FOV: 45 degrees; 1469x1471.
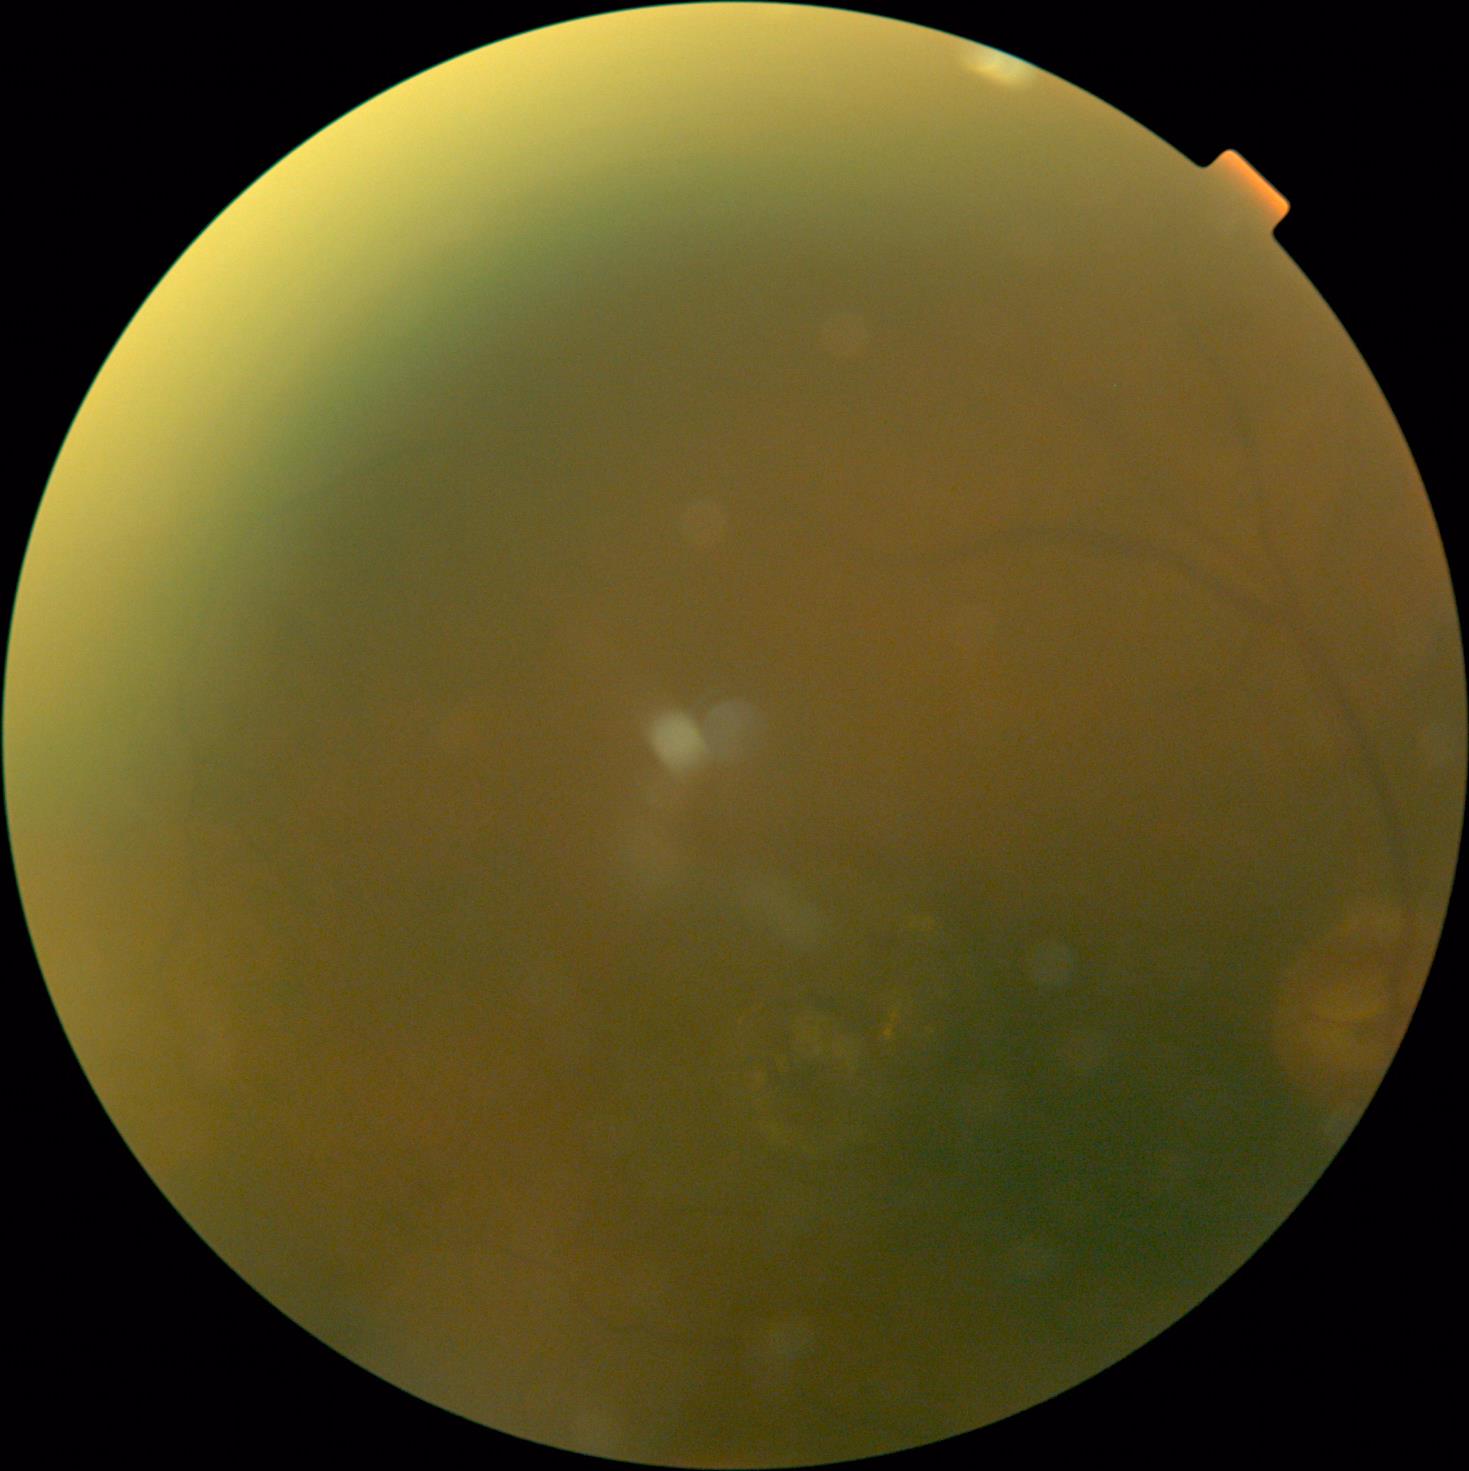

DR stage=ungradable; image quality=insufficient for DR assessment.